Central posterior field.
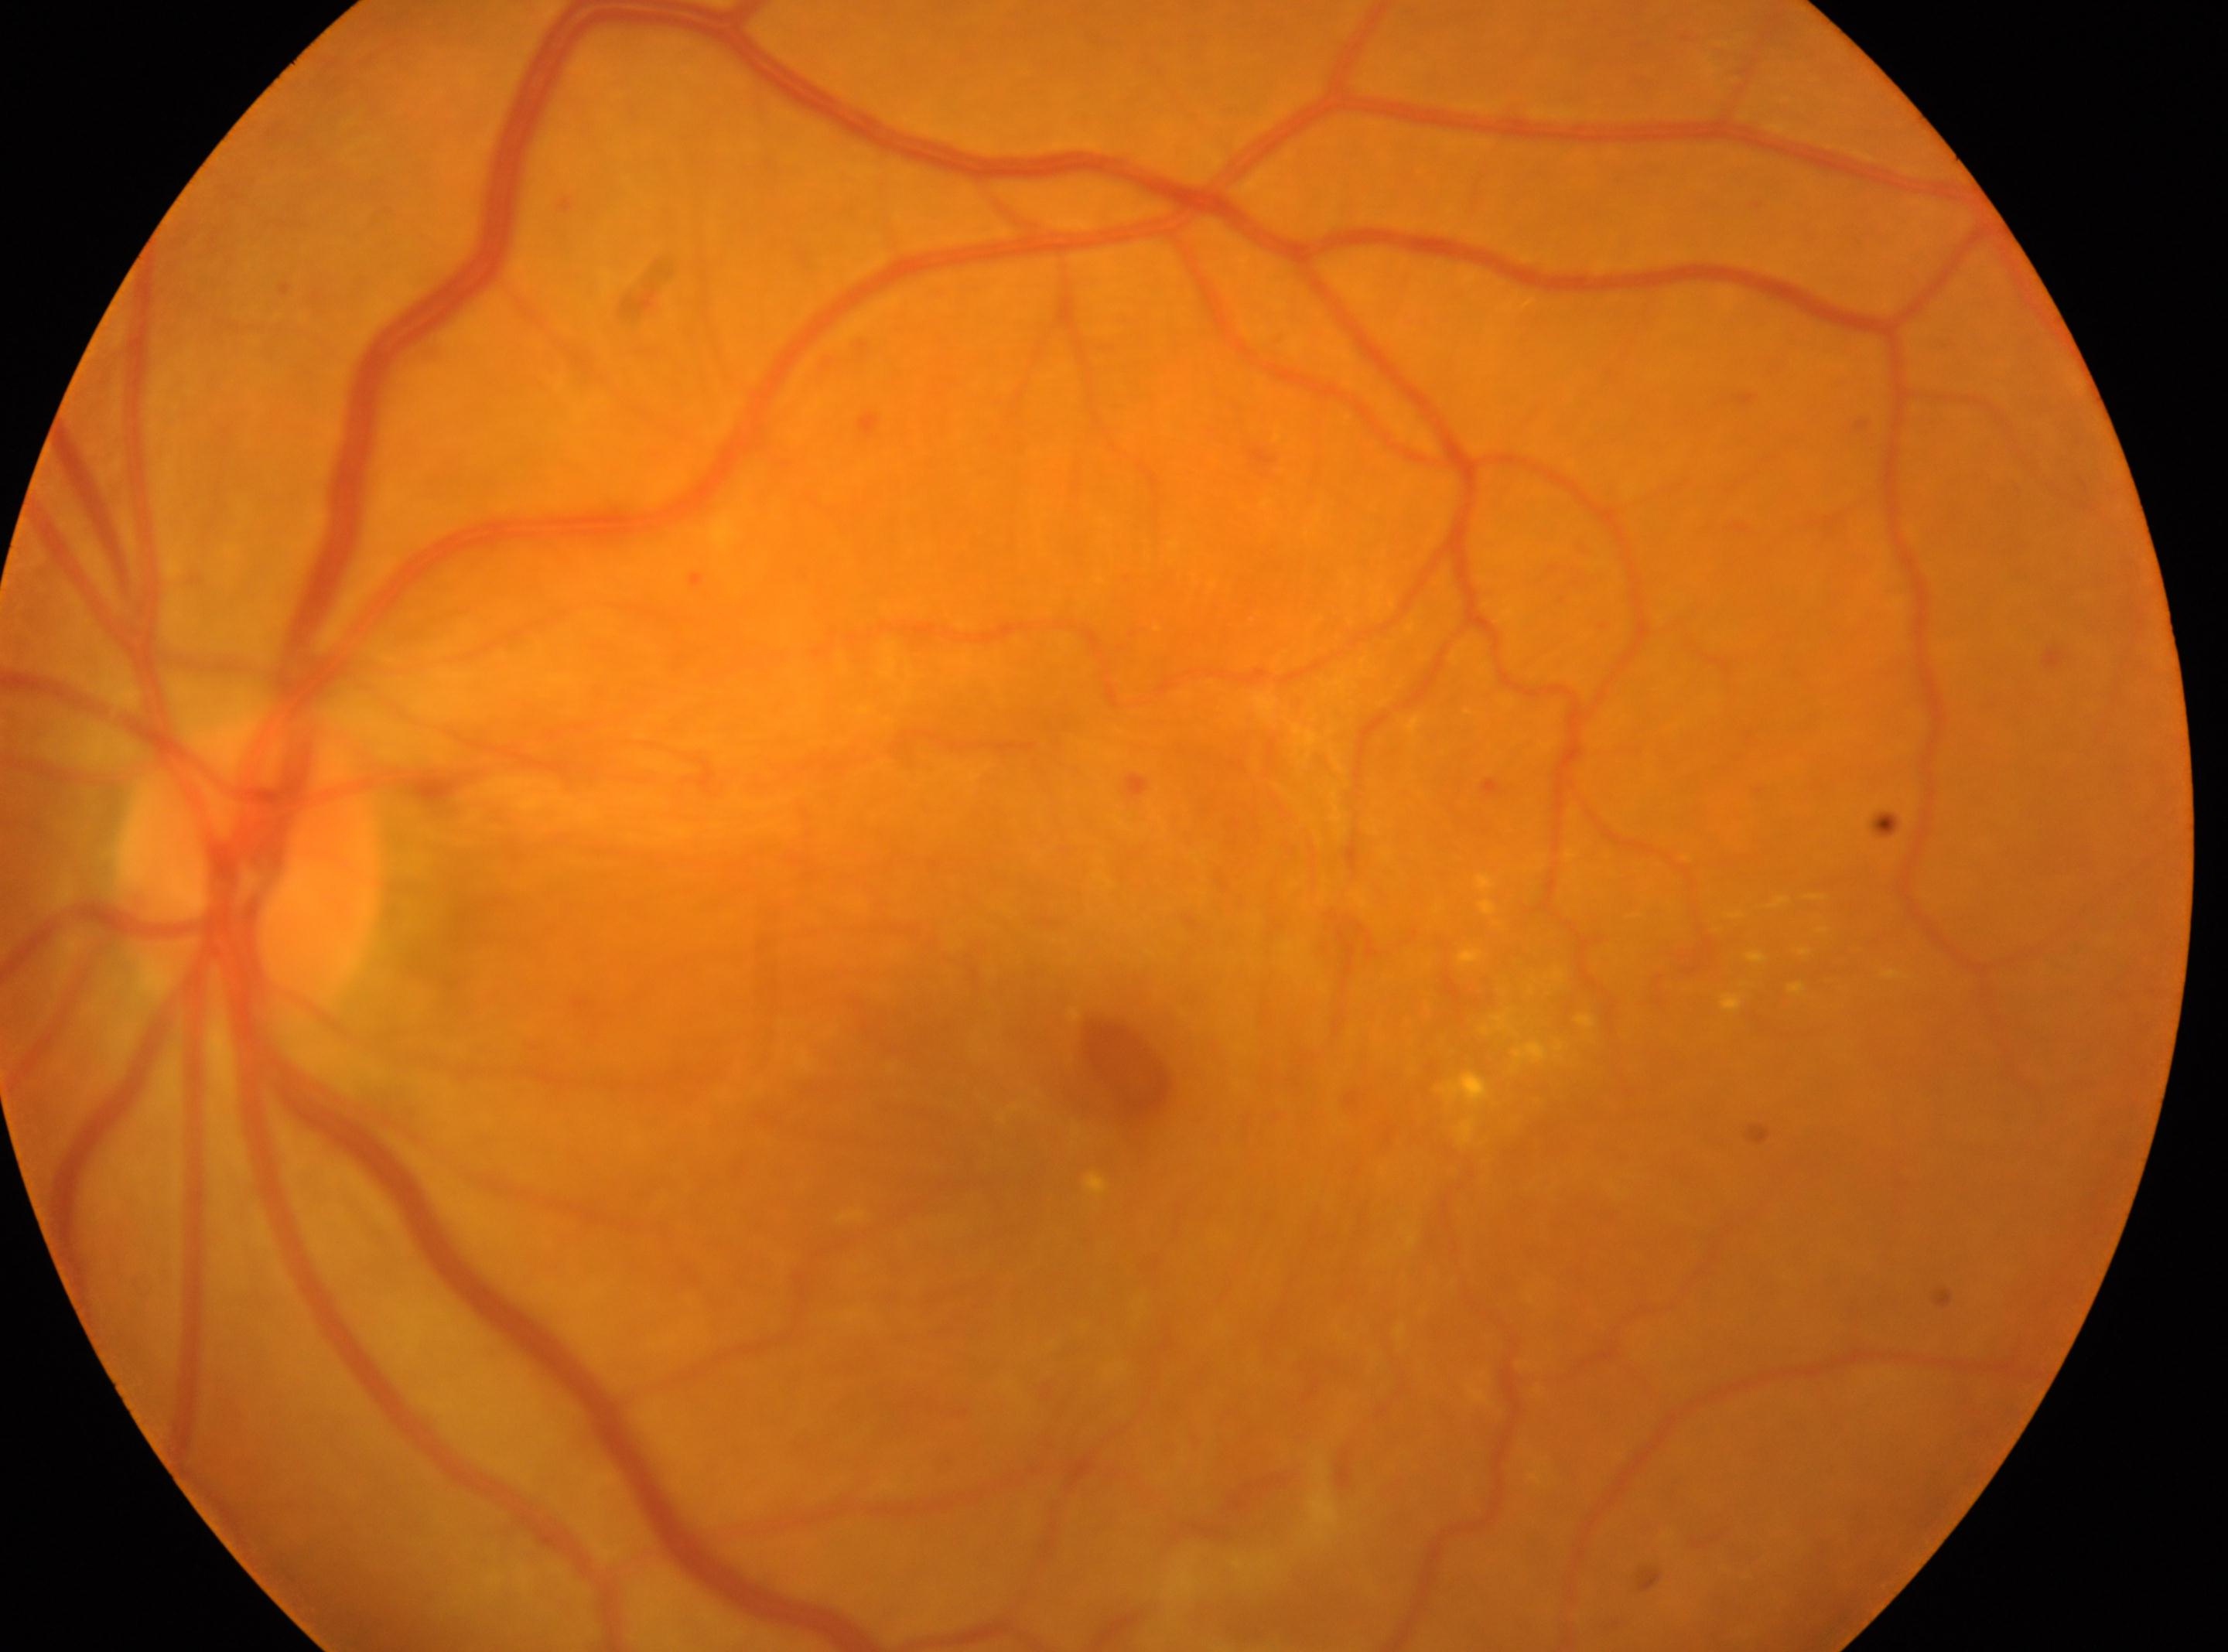

| key | value |
|---|---|
| eye | OS |
| retinopathy grade | proliferative diabetic retinopathy (4) |
| fovea center | (x=1134, y=1073) |
| optic disc | (x=250, y=870) |